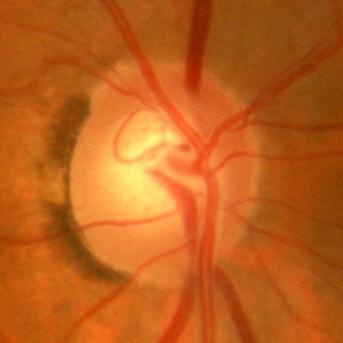

ONH-centered fundus image showing no glaucoma.